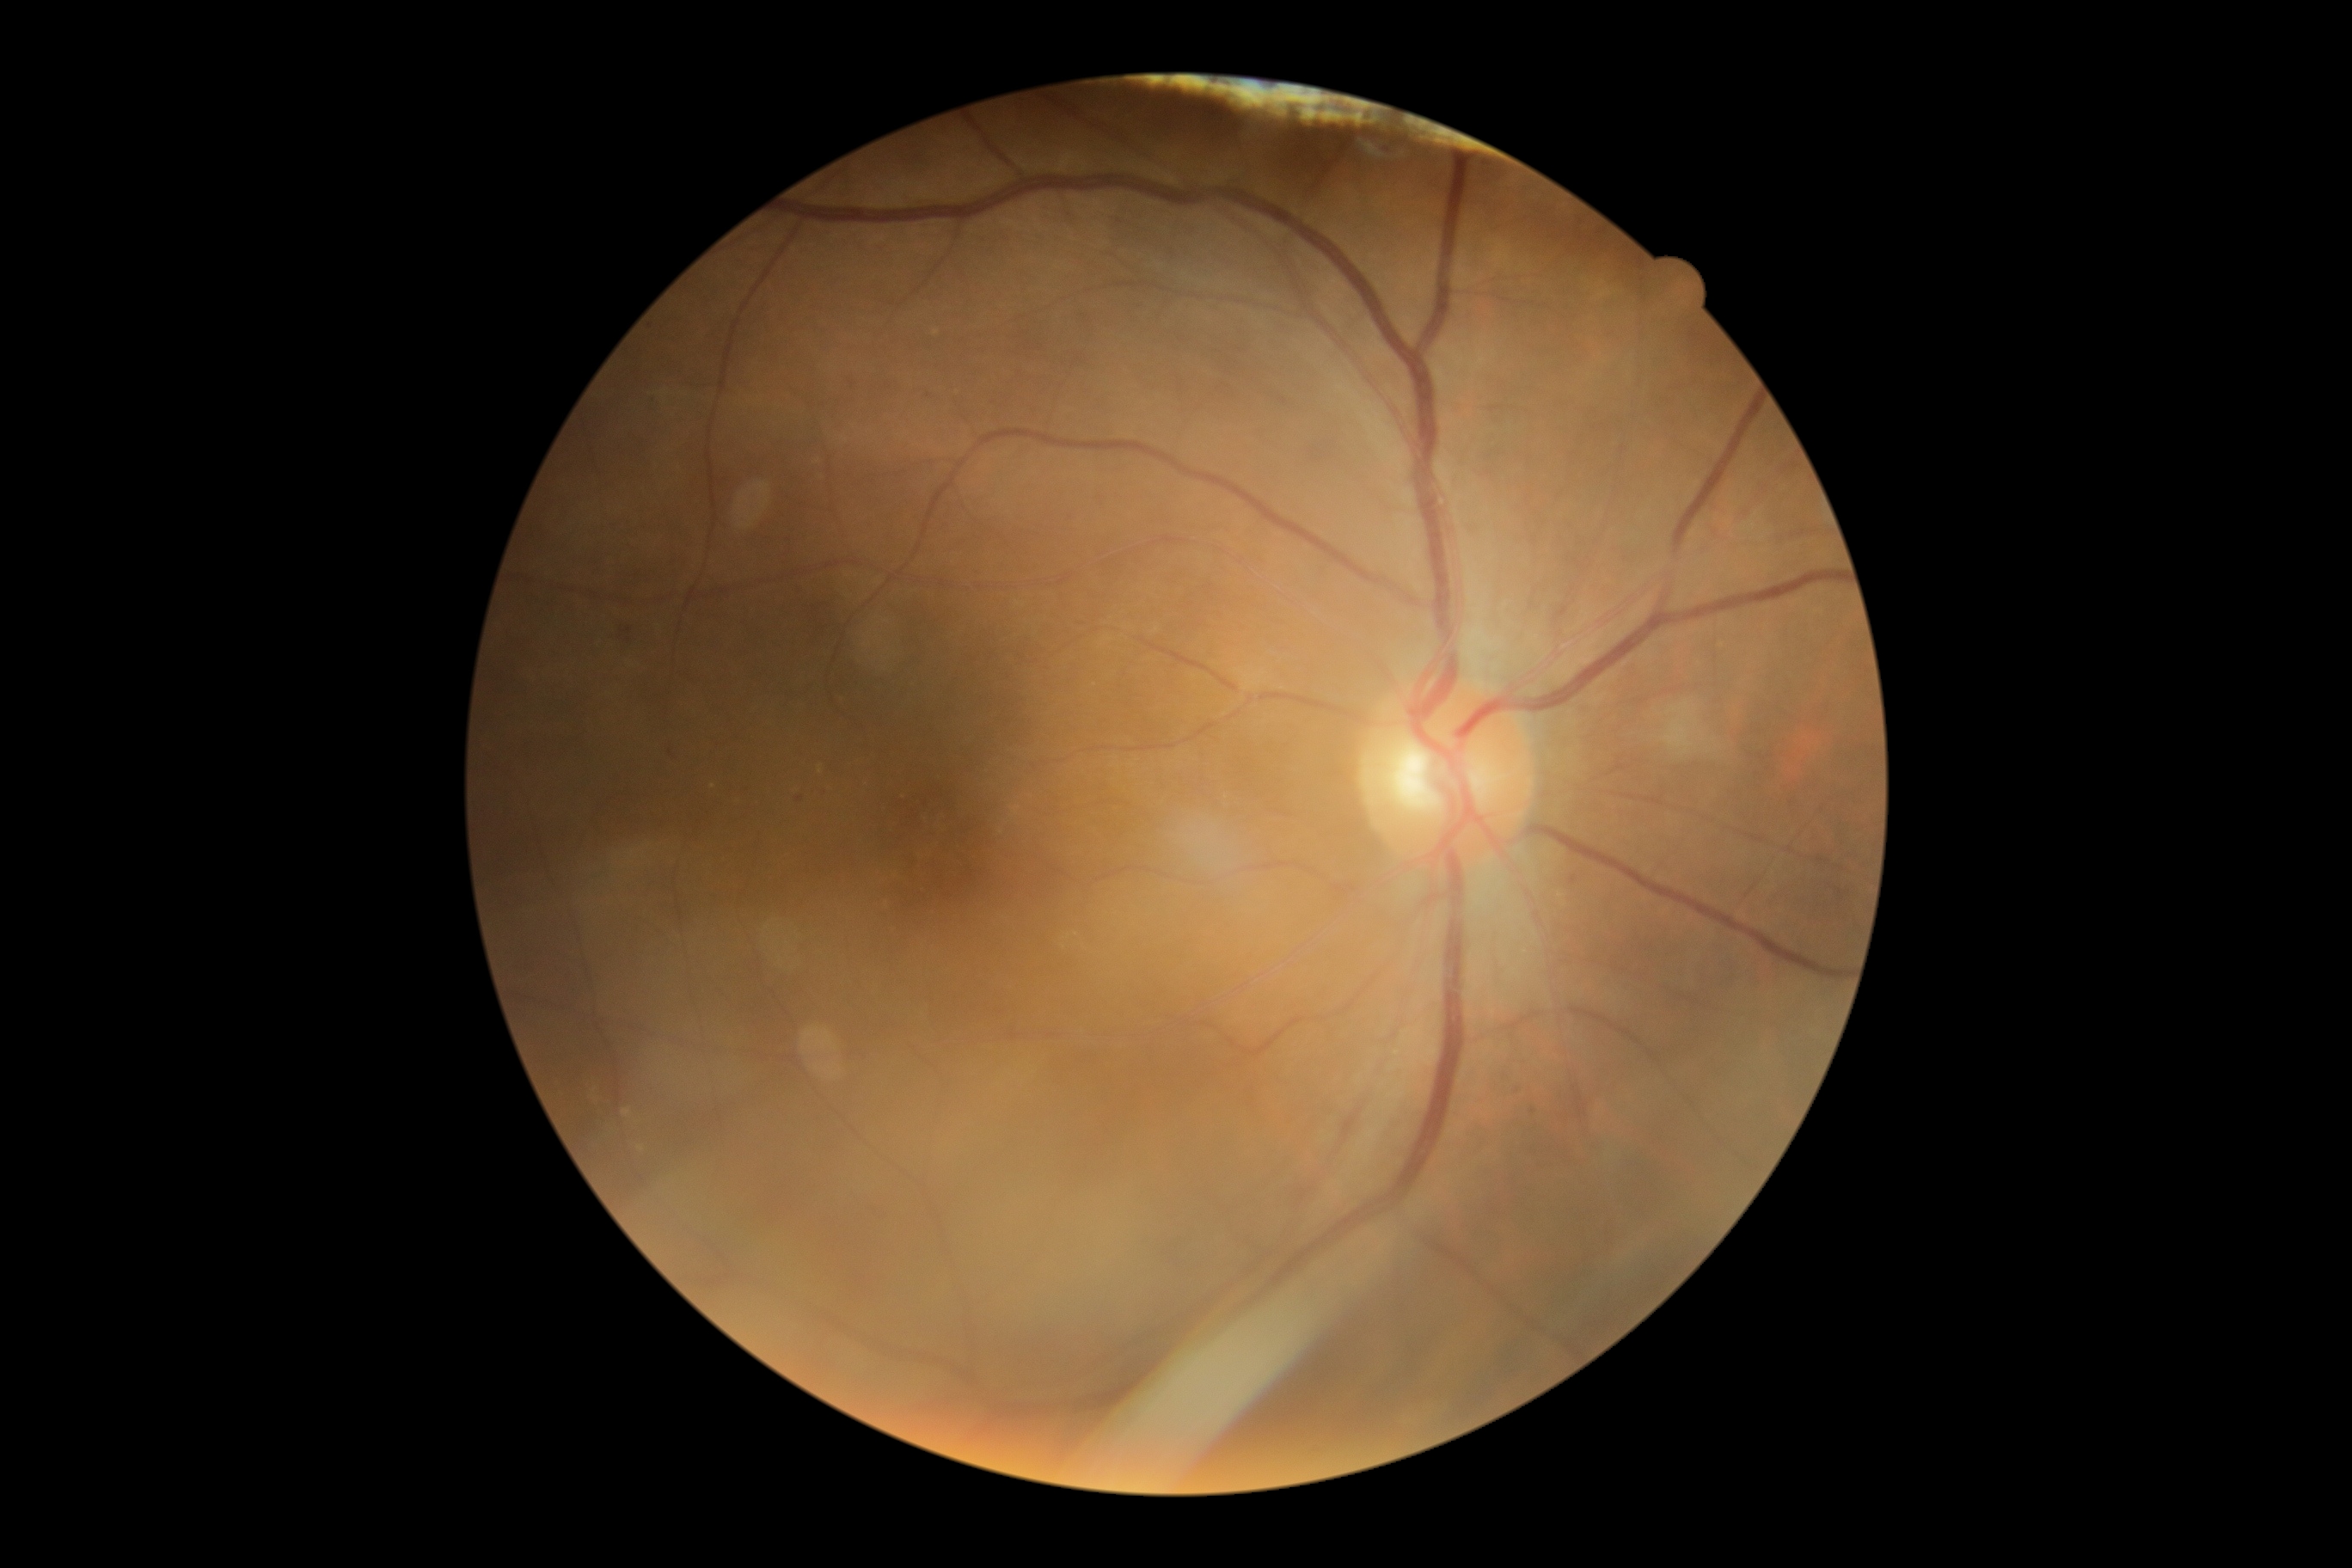 DR grade: 2/4.
The retinopathy is classified as non-proliferative diabetic retinopathy.